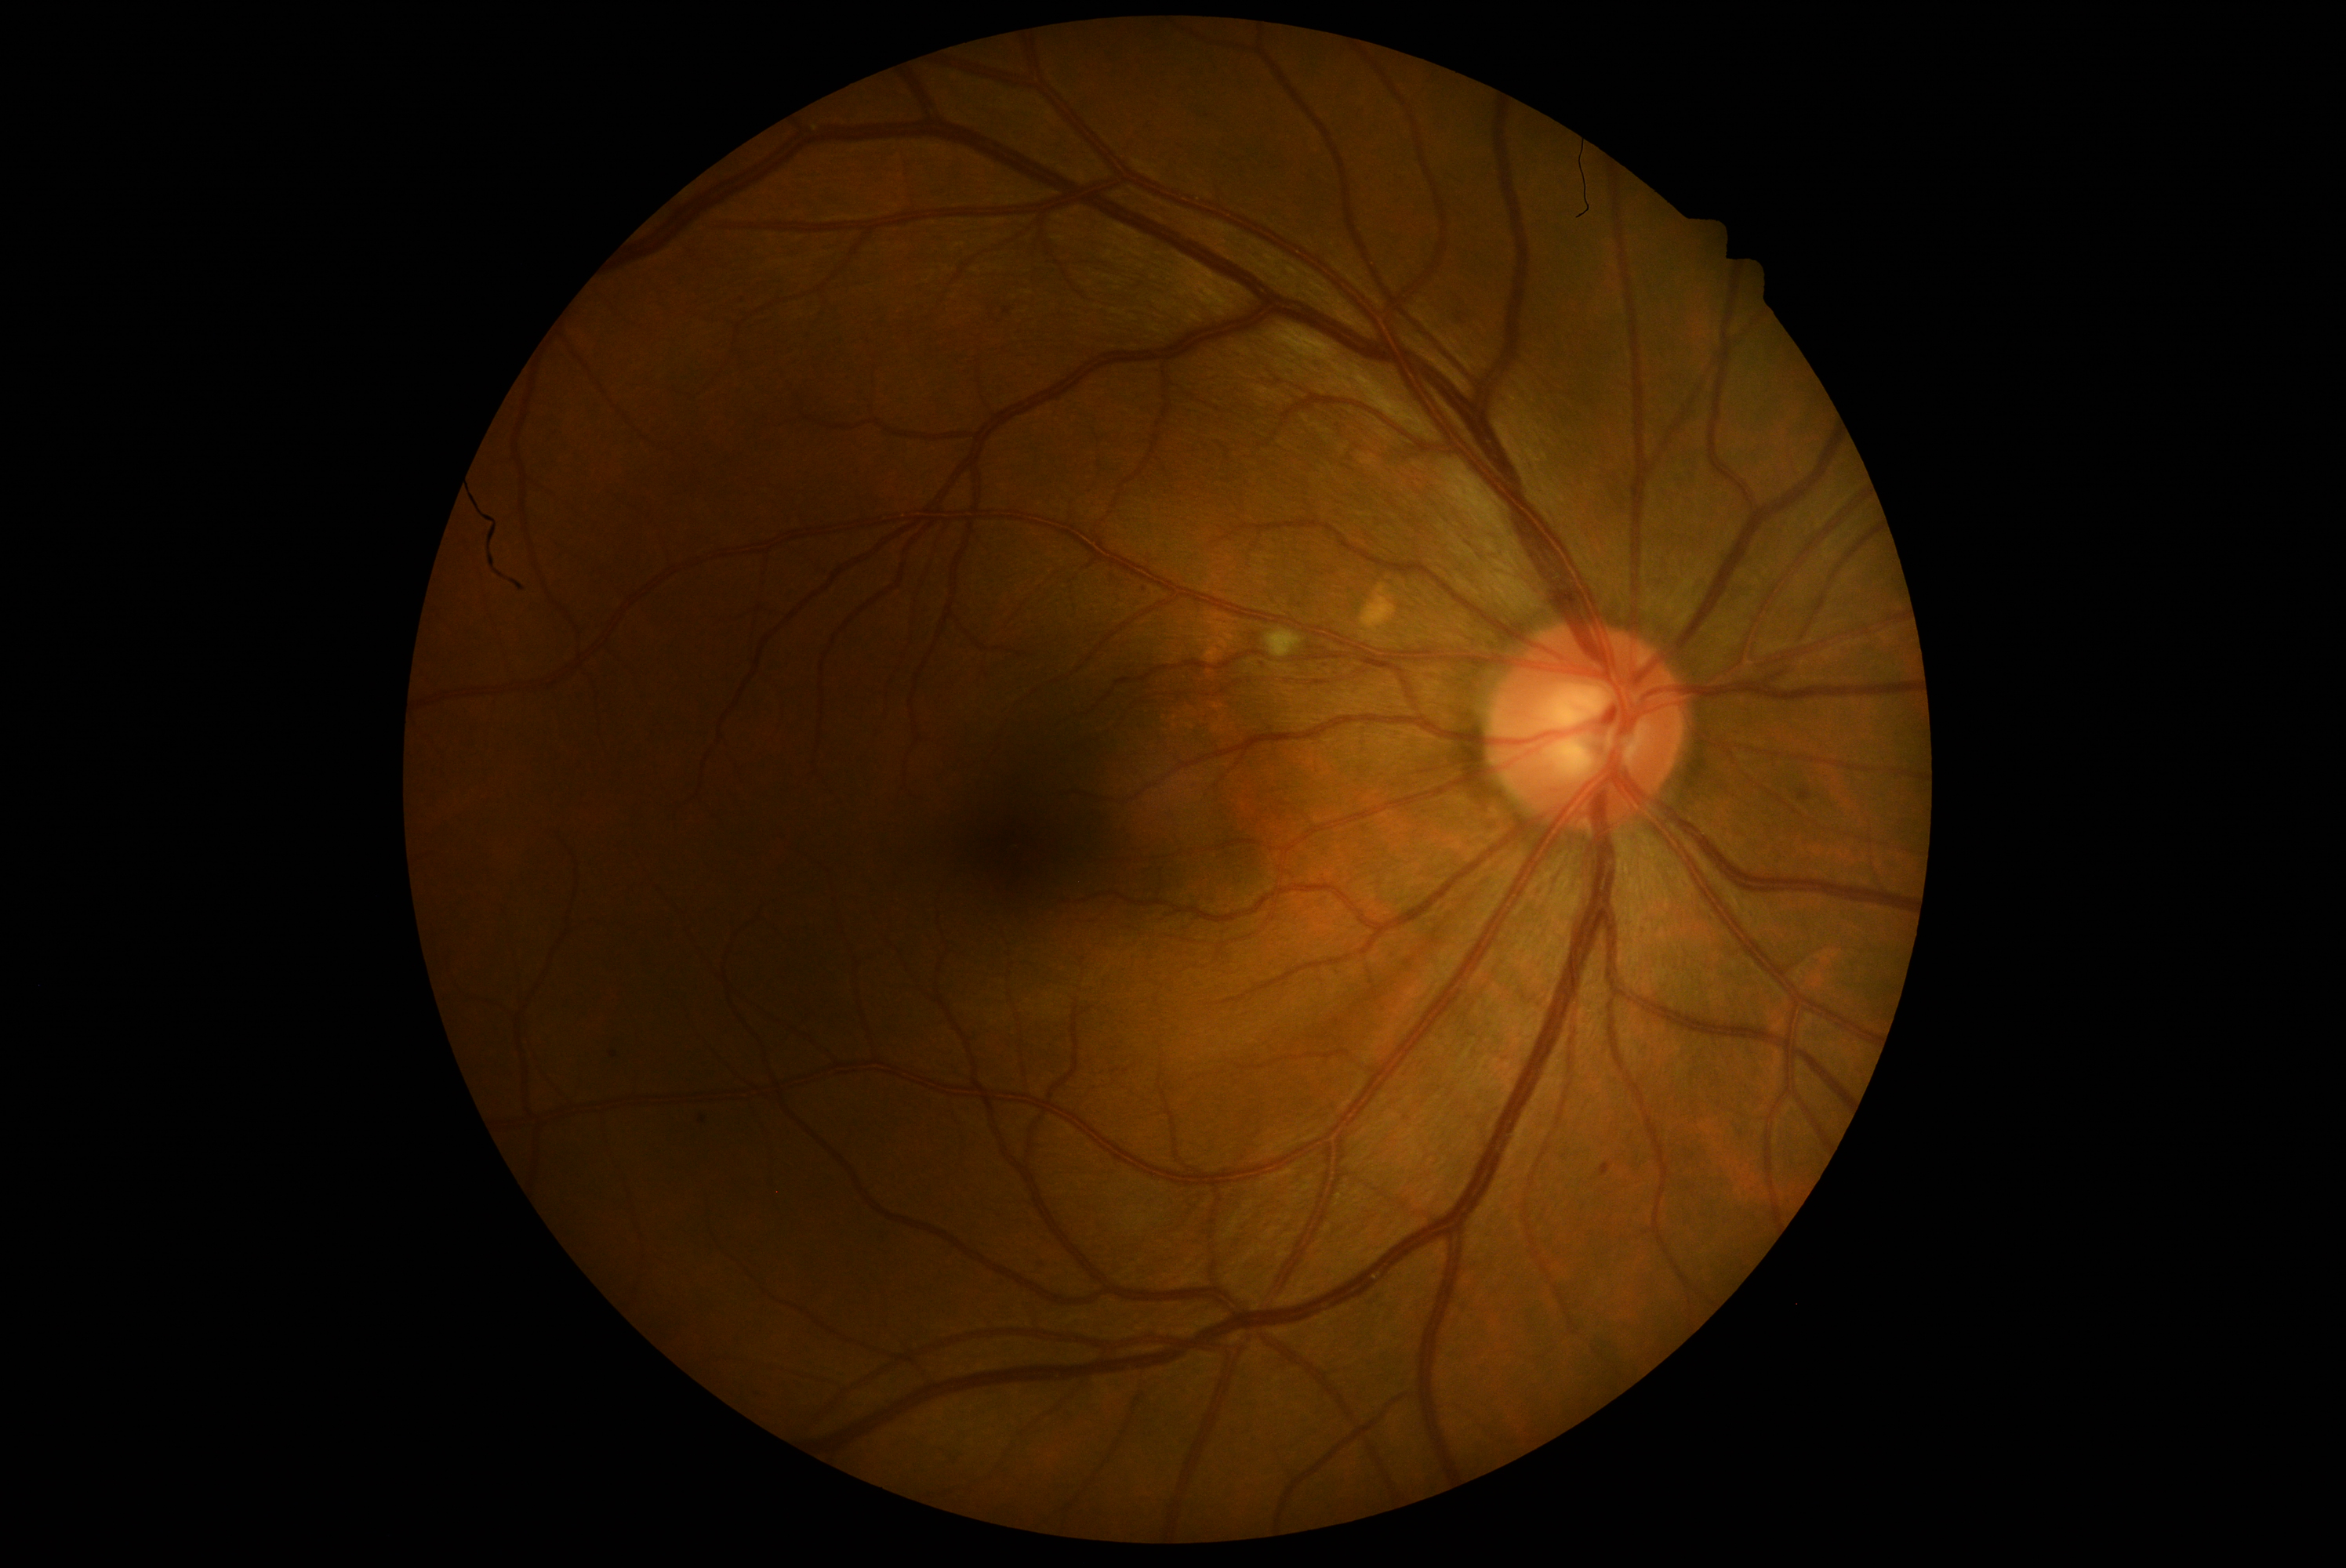
diabetic retinopathy grade: 2 — more than just microaneurysms but less than severe NPDR; DR class: non-proliferative diabetic retinopathy.